Acquired with a NIDEK AFC-230 · 848x848px · without pupil dilation.
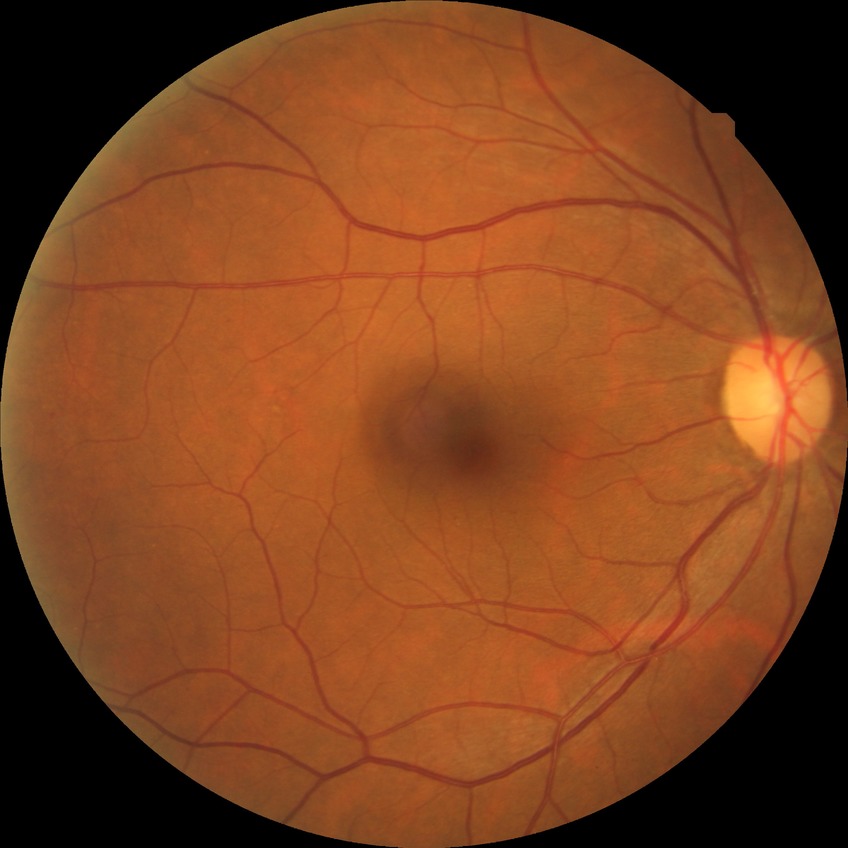

DR class=non-proliferative diabetic retinopathy; DR grade=SDR.